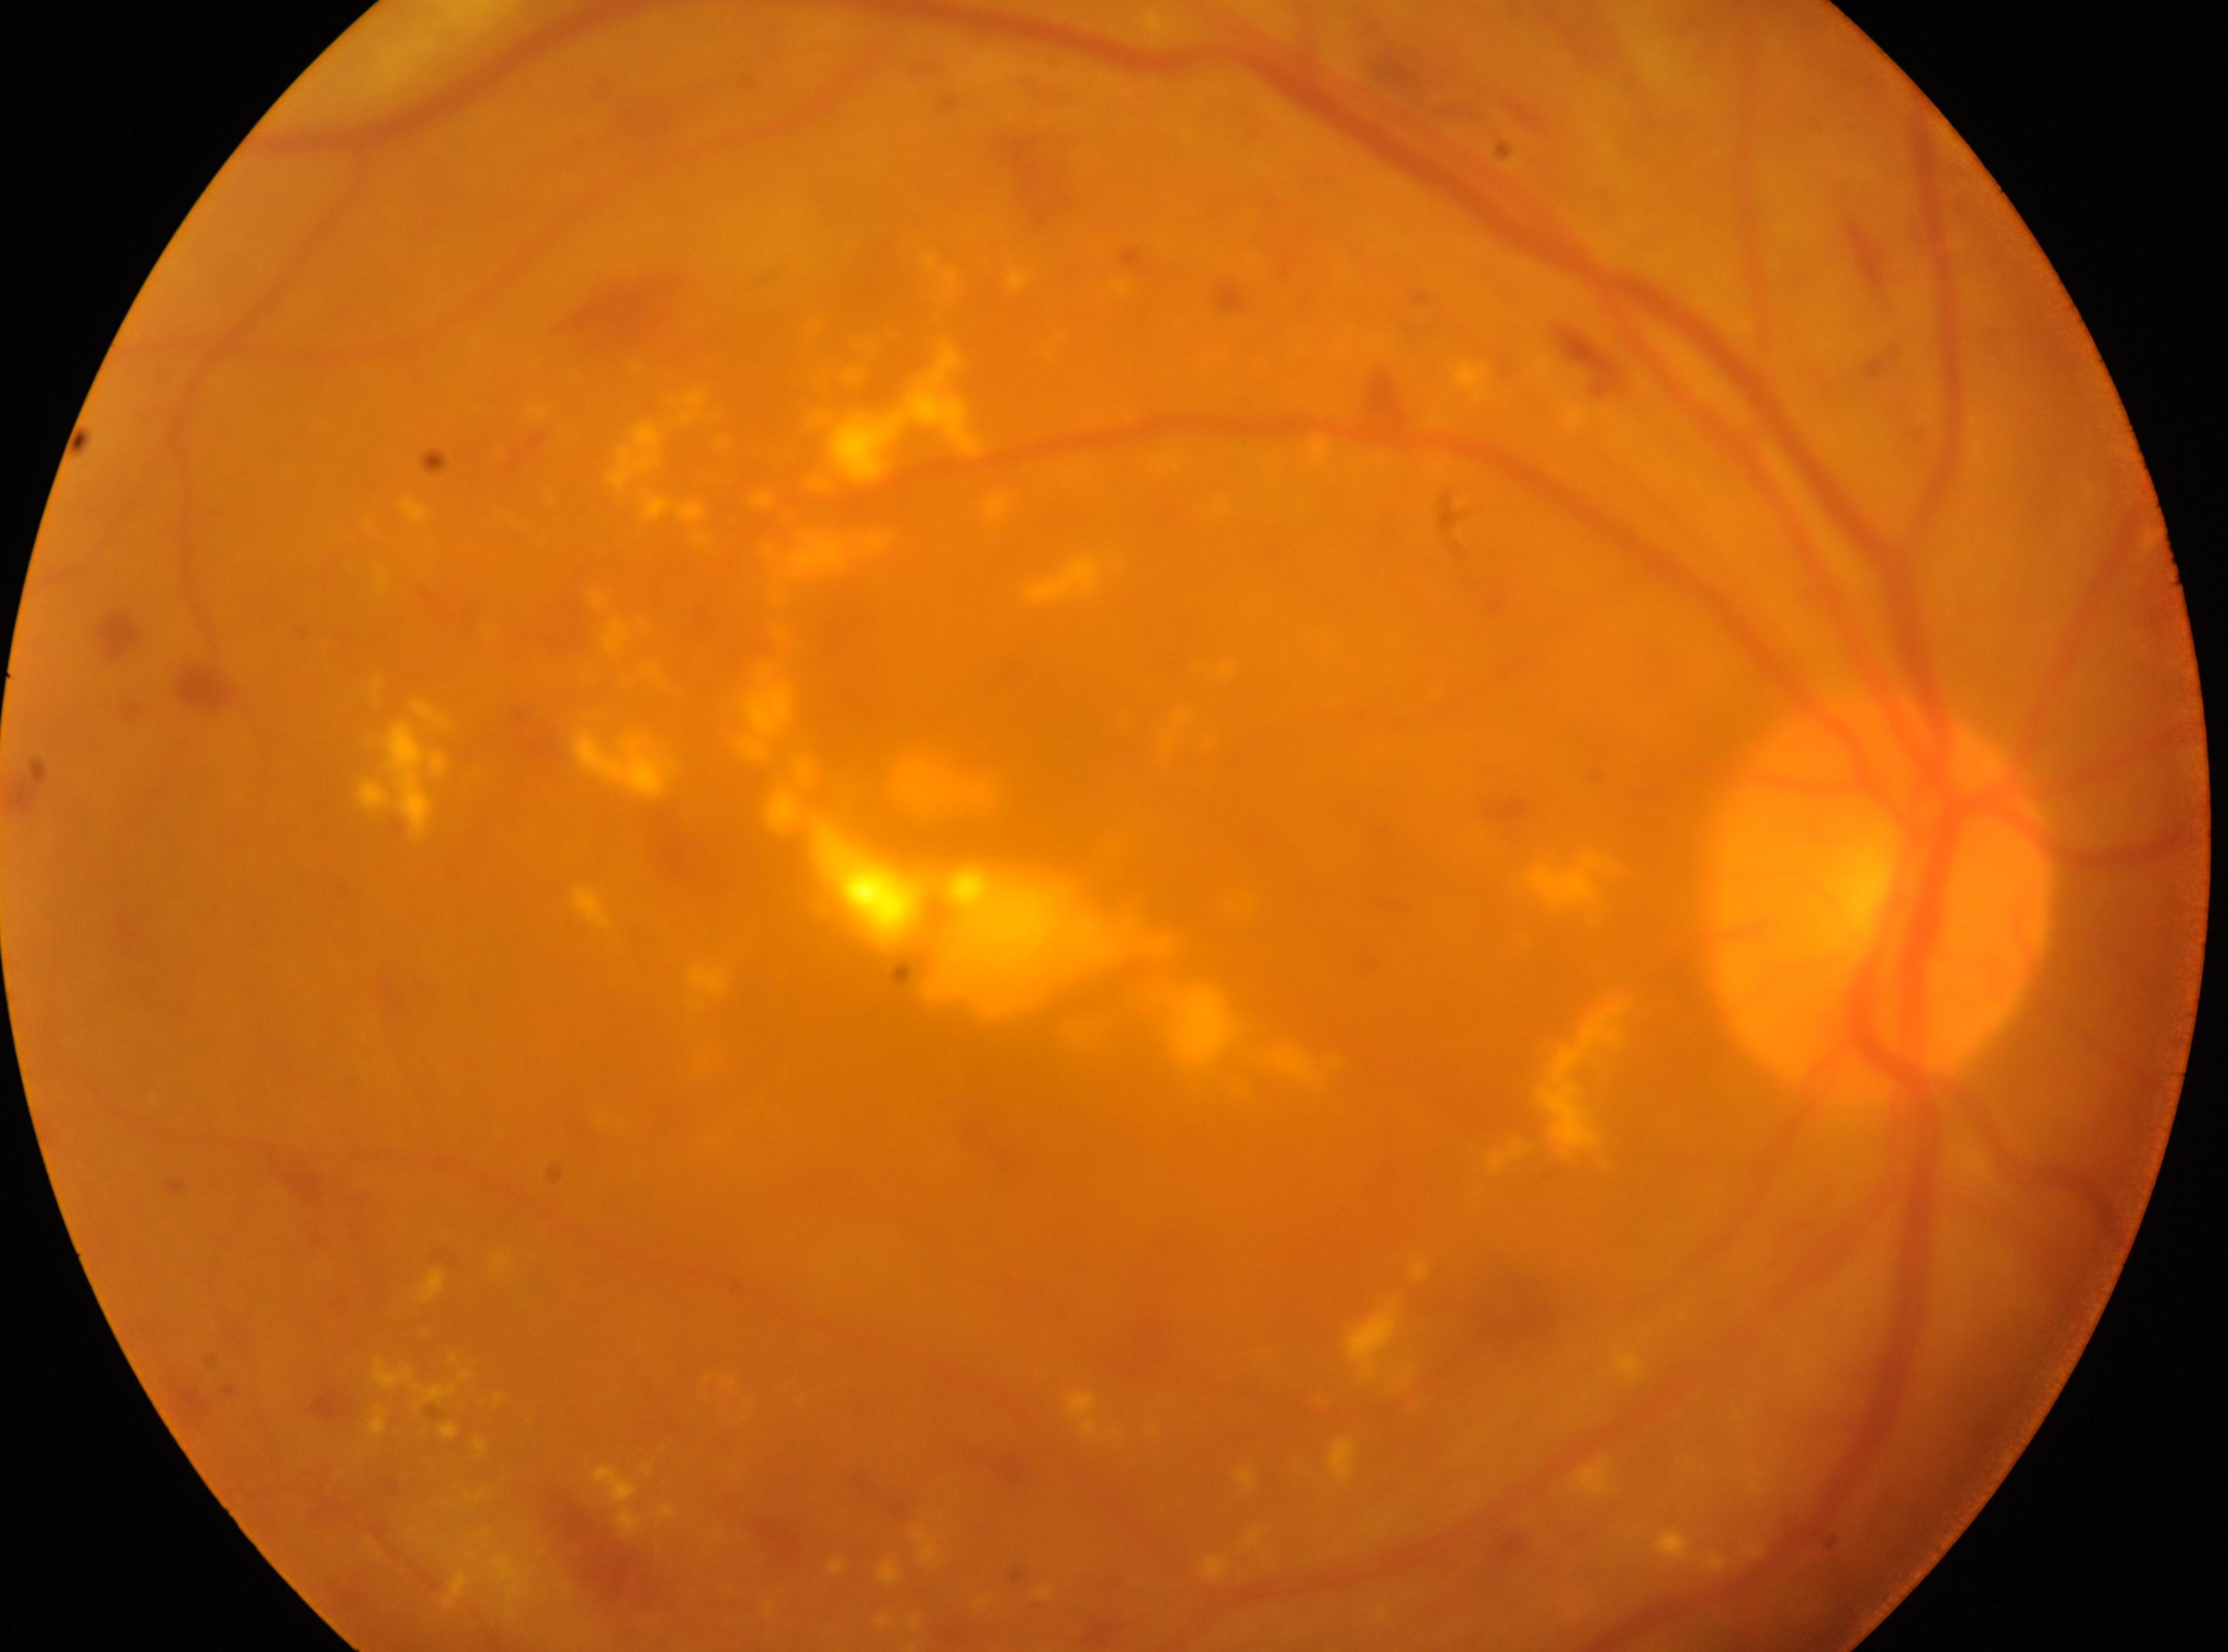

* optic disc center — (x=1878, y=896)
* laterality — right
* diabetic retinopathy severity — grade 2
* fovea centralis — (x=1097, y=973)